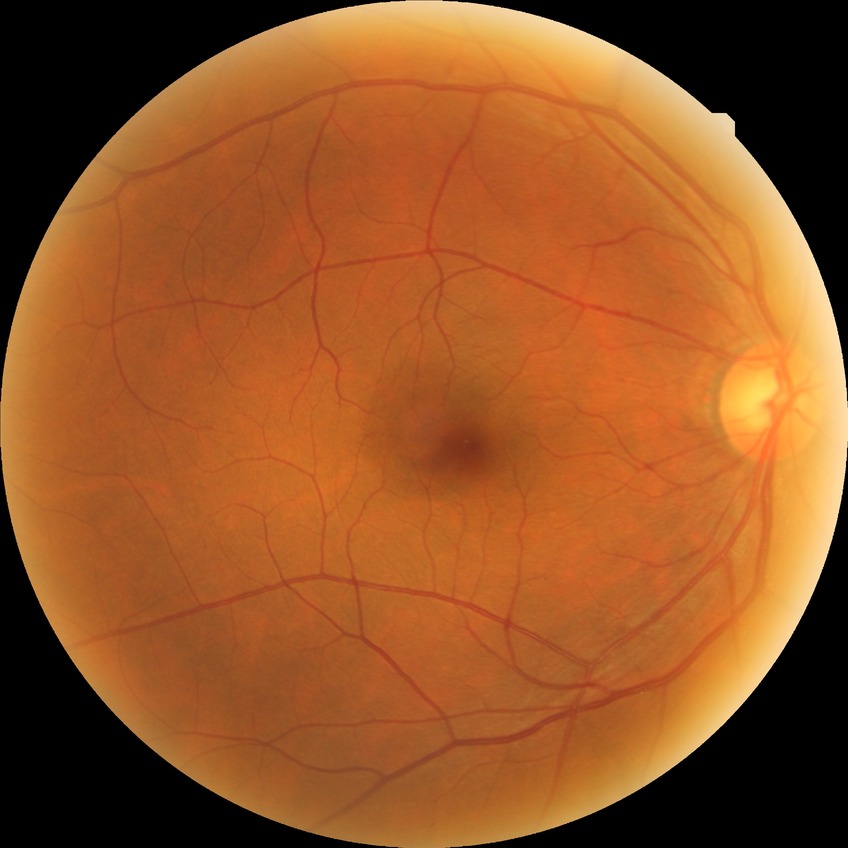

Davis stage is NDR.